1534x1534px
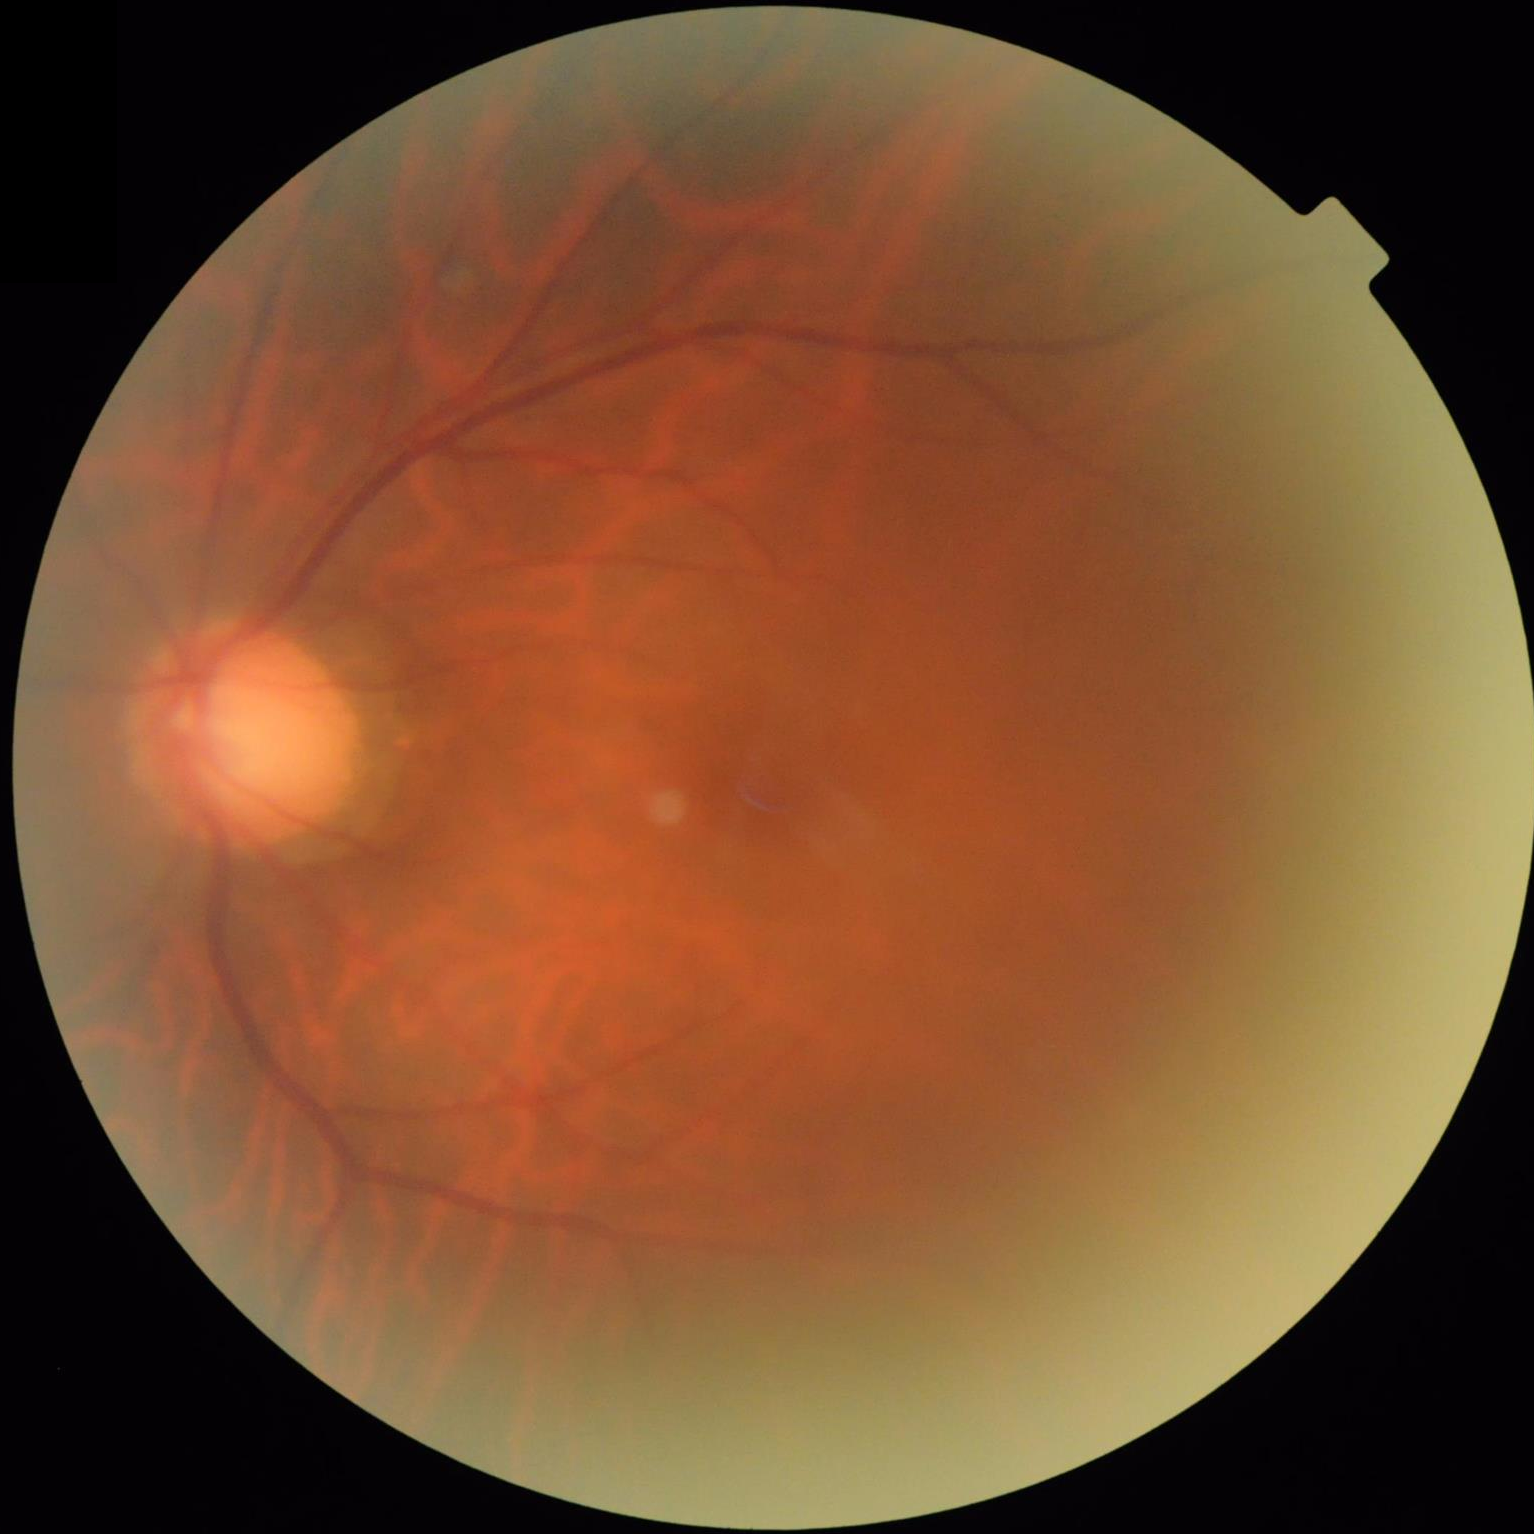

Illumination is uneven. Out of focus; structures are indistinct. Adequate contrast for distinguishing structures. Image quality is suboptimal.